640 x 480 pixels. Clarity RetCam 3, 130° FOV. RetCam wide-field infant fundus image.
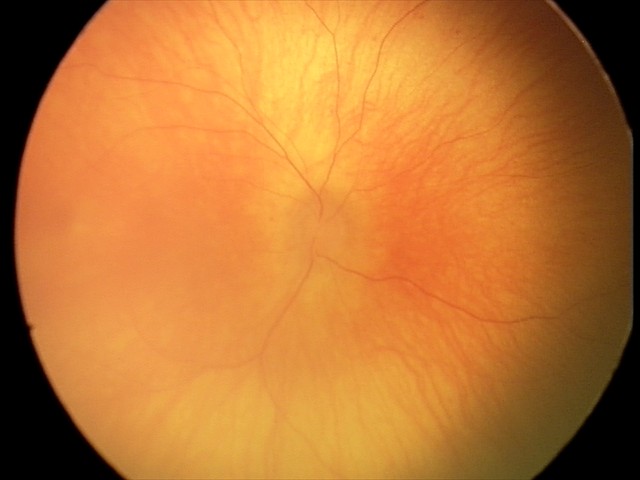
Impression = physiological appearance.